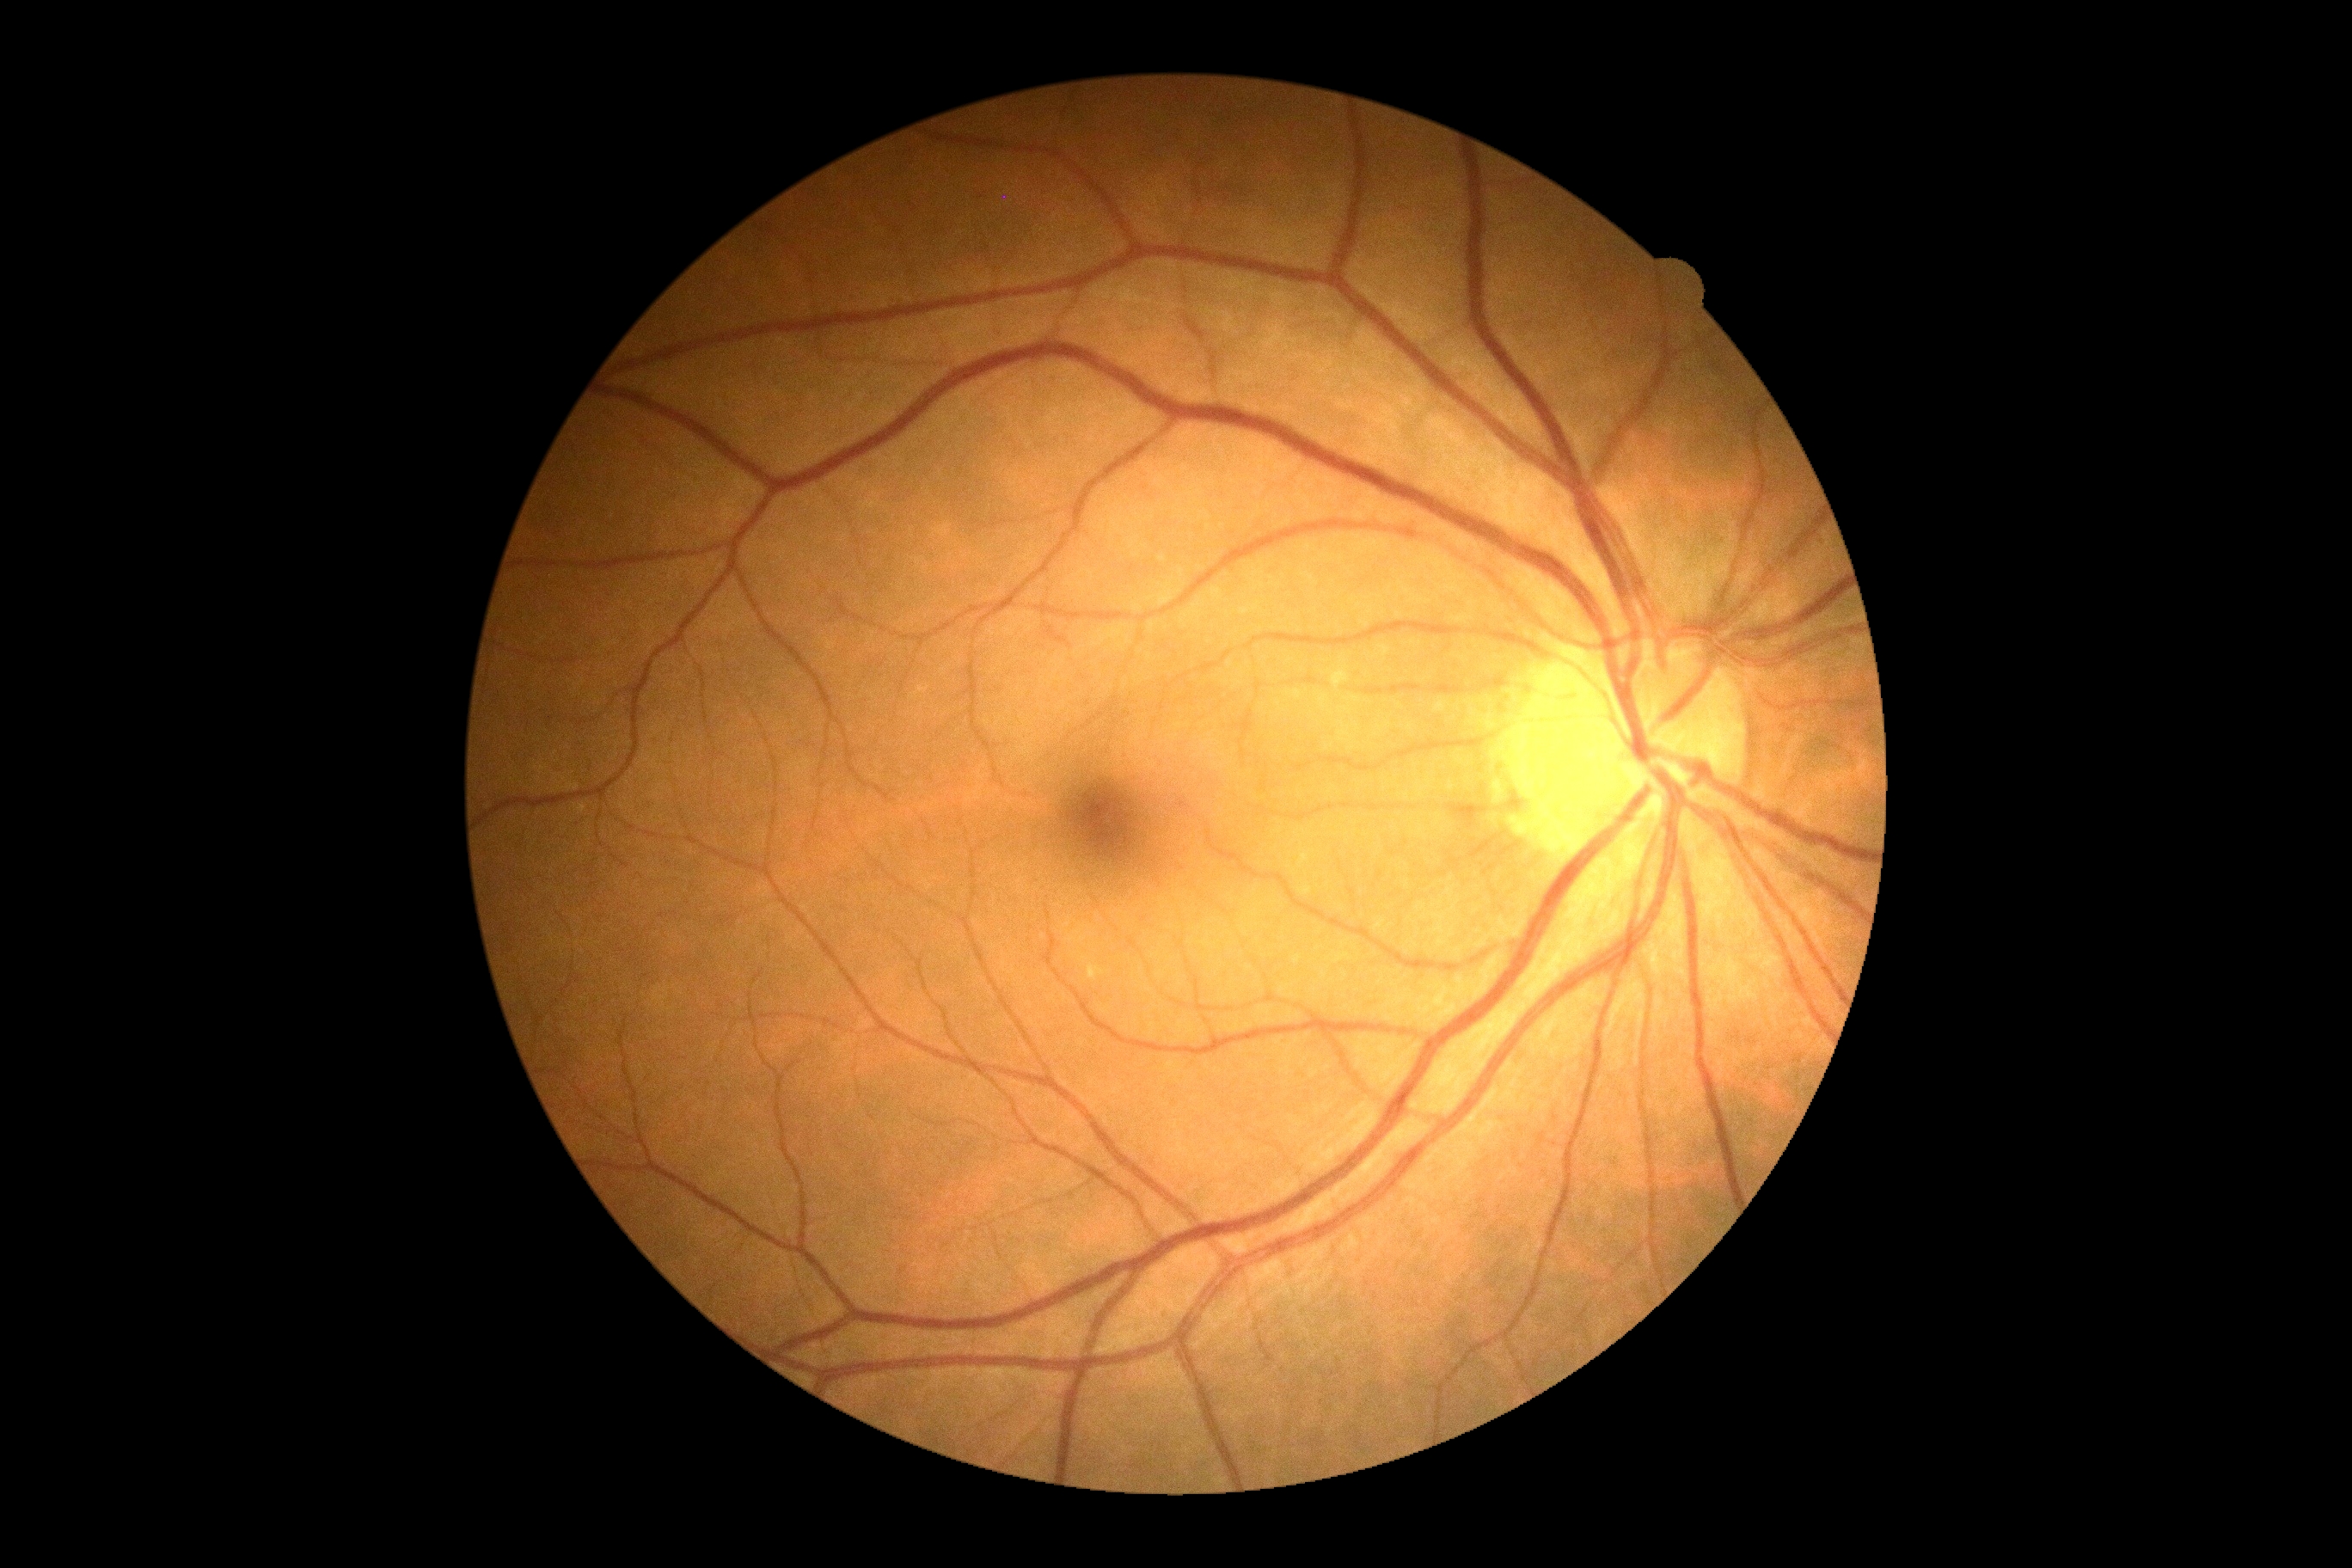

retinopathy grade@0 (no apparent retinopathy).